FOV: 45 degrees; 848 by 848 pixels; camera: NIDEK AFC-230:
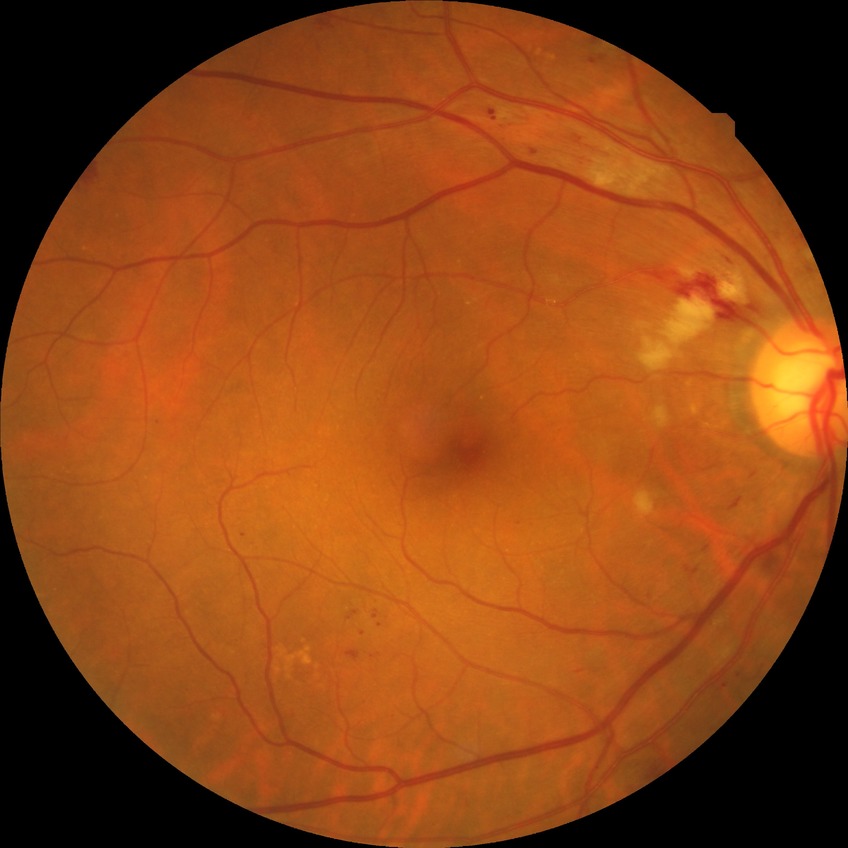 Diabetic retinopathy (DR) is pre-proliferative diabetic retinopathy (PPDR).